Color fundus photograph: 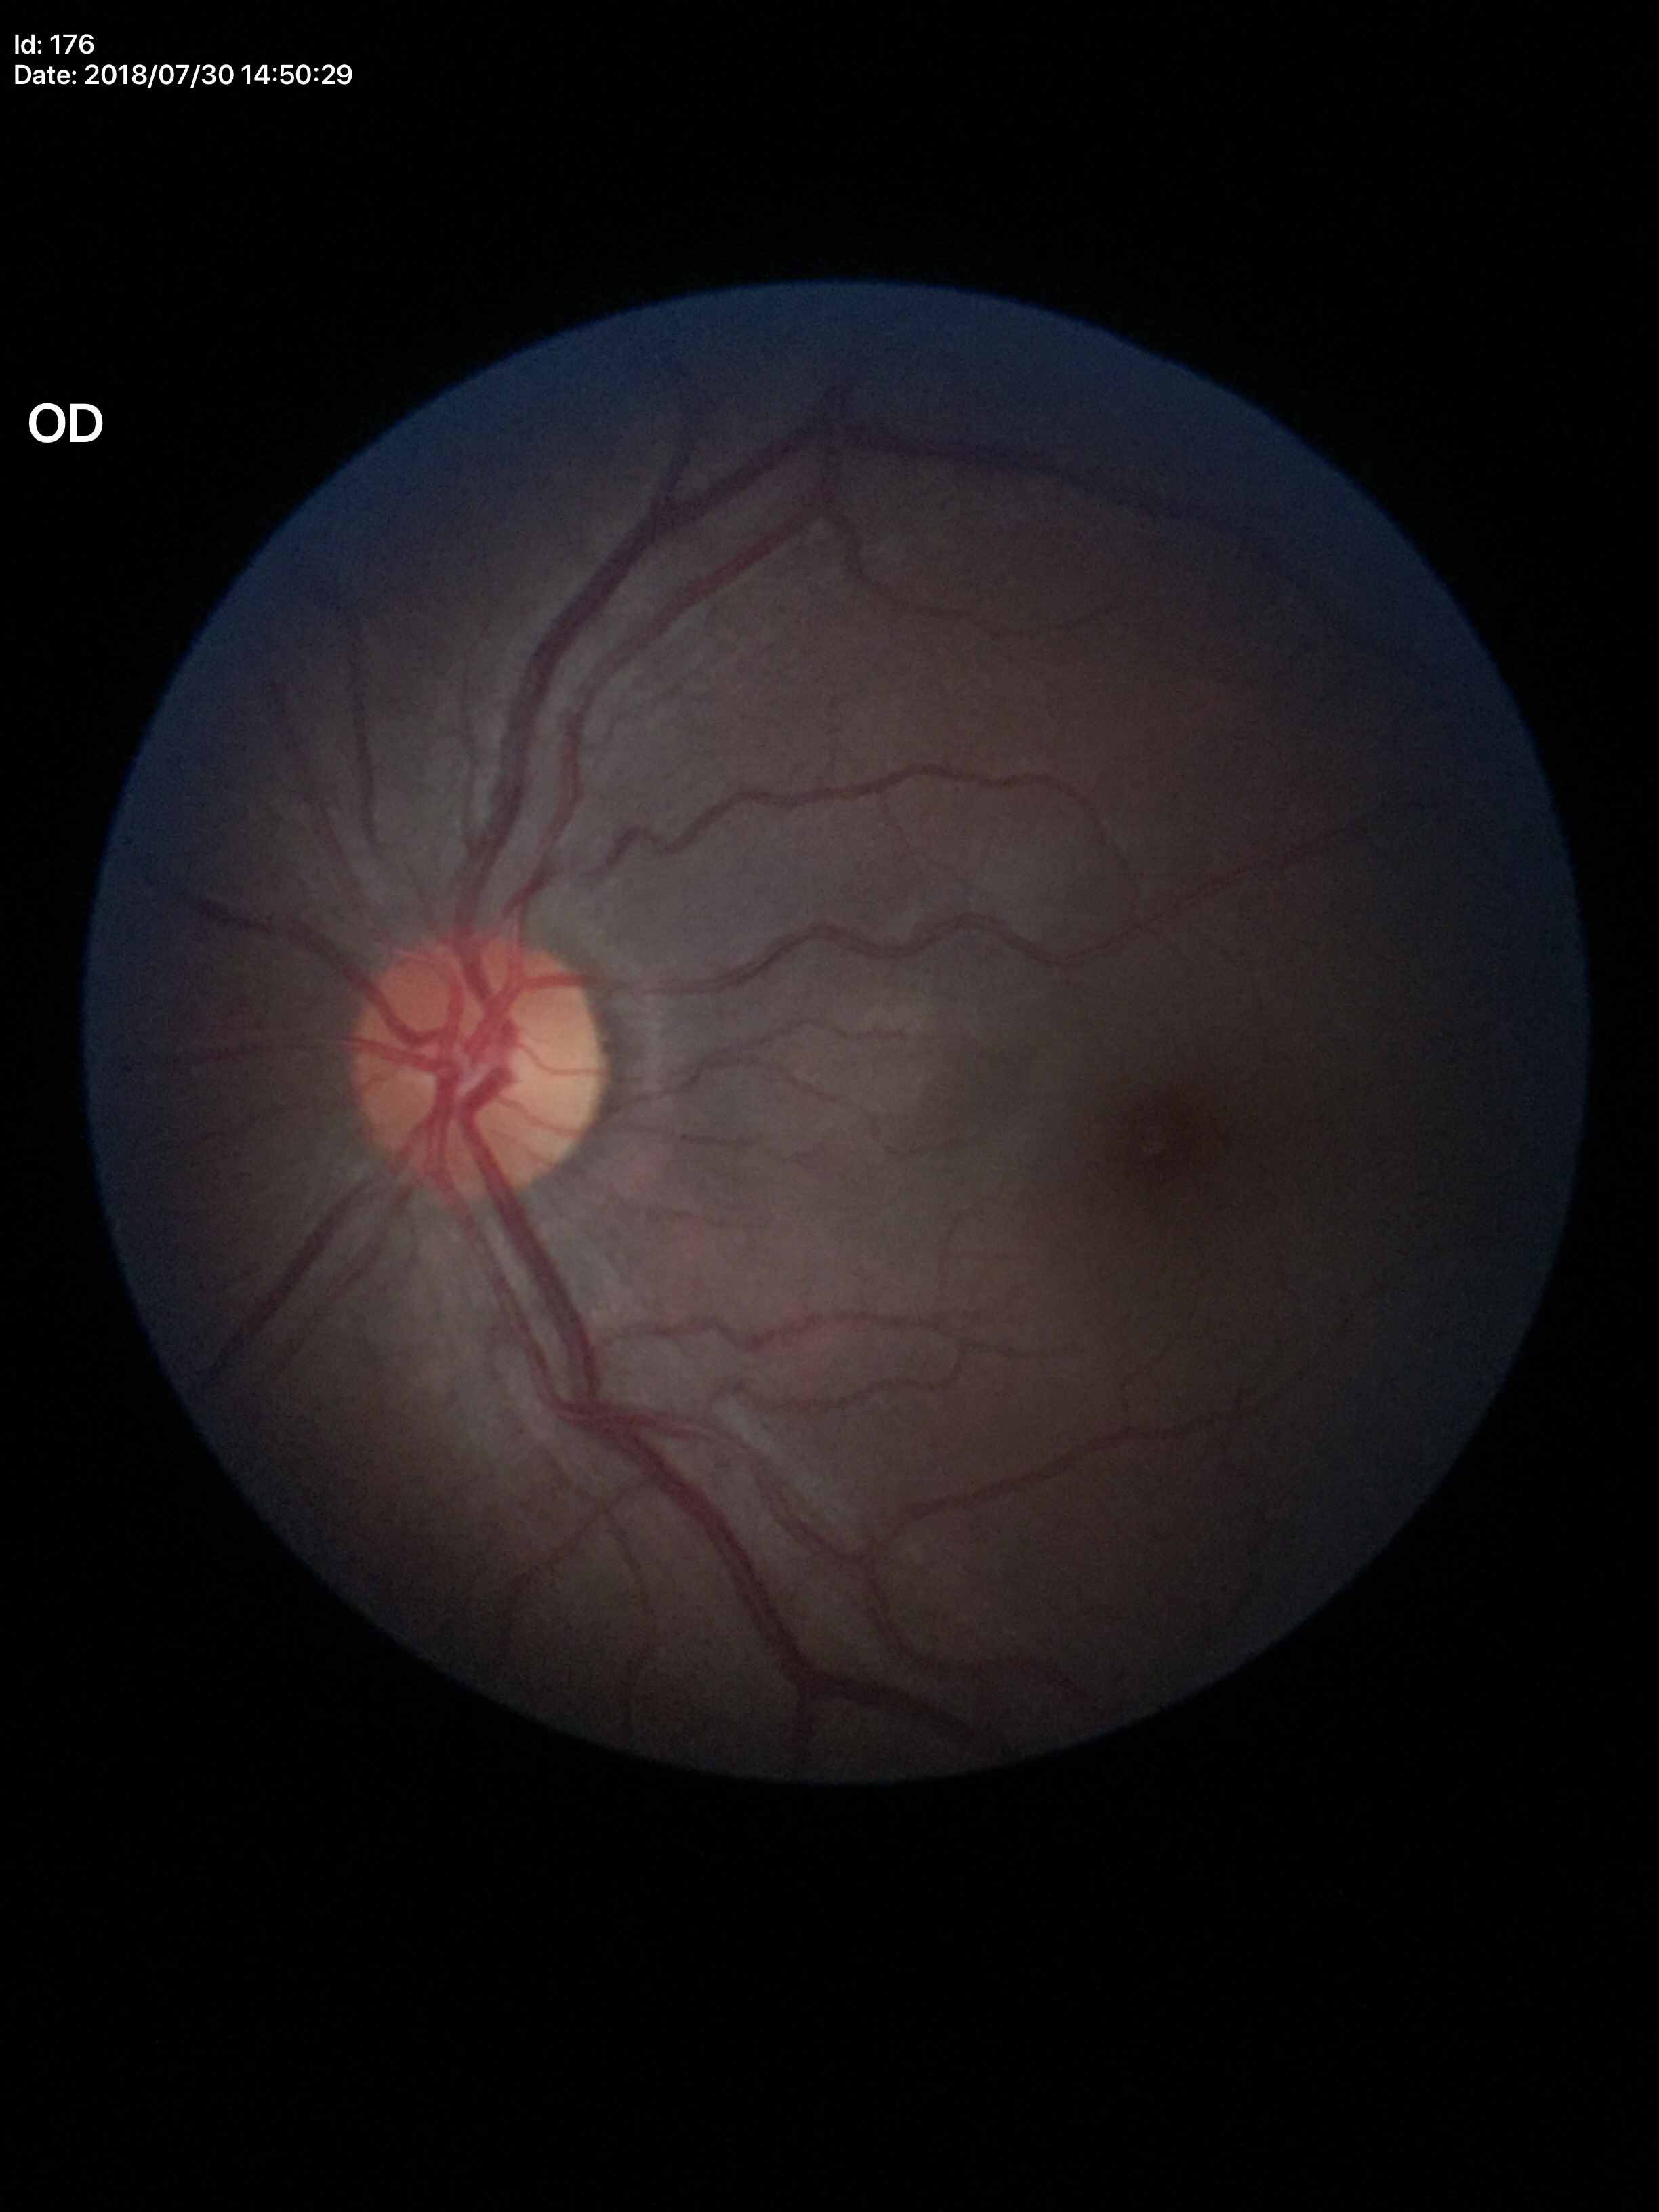 Findings:
* Glaucoma screening · no suspicious findings (all 5 graders called normal)
* vertical cup-disc ratio (VCDR) · 0.48
* area CDR (ACDR) · 0.23